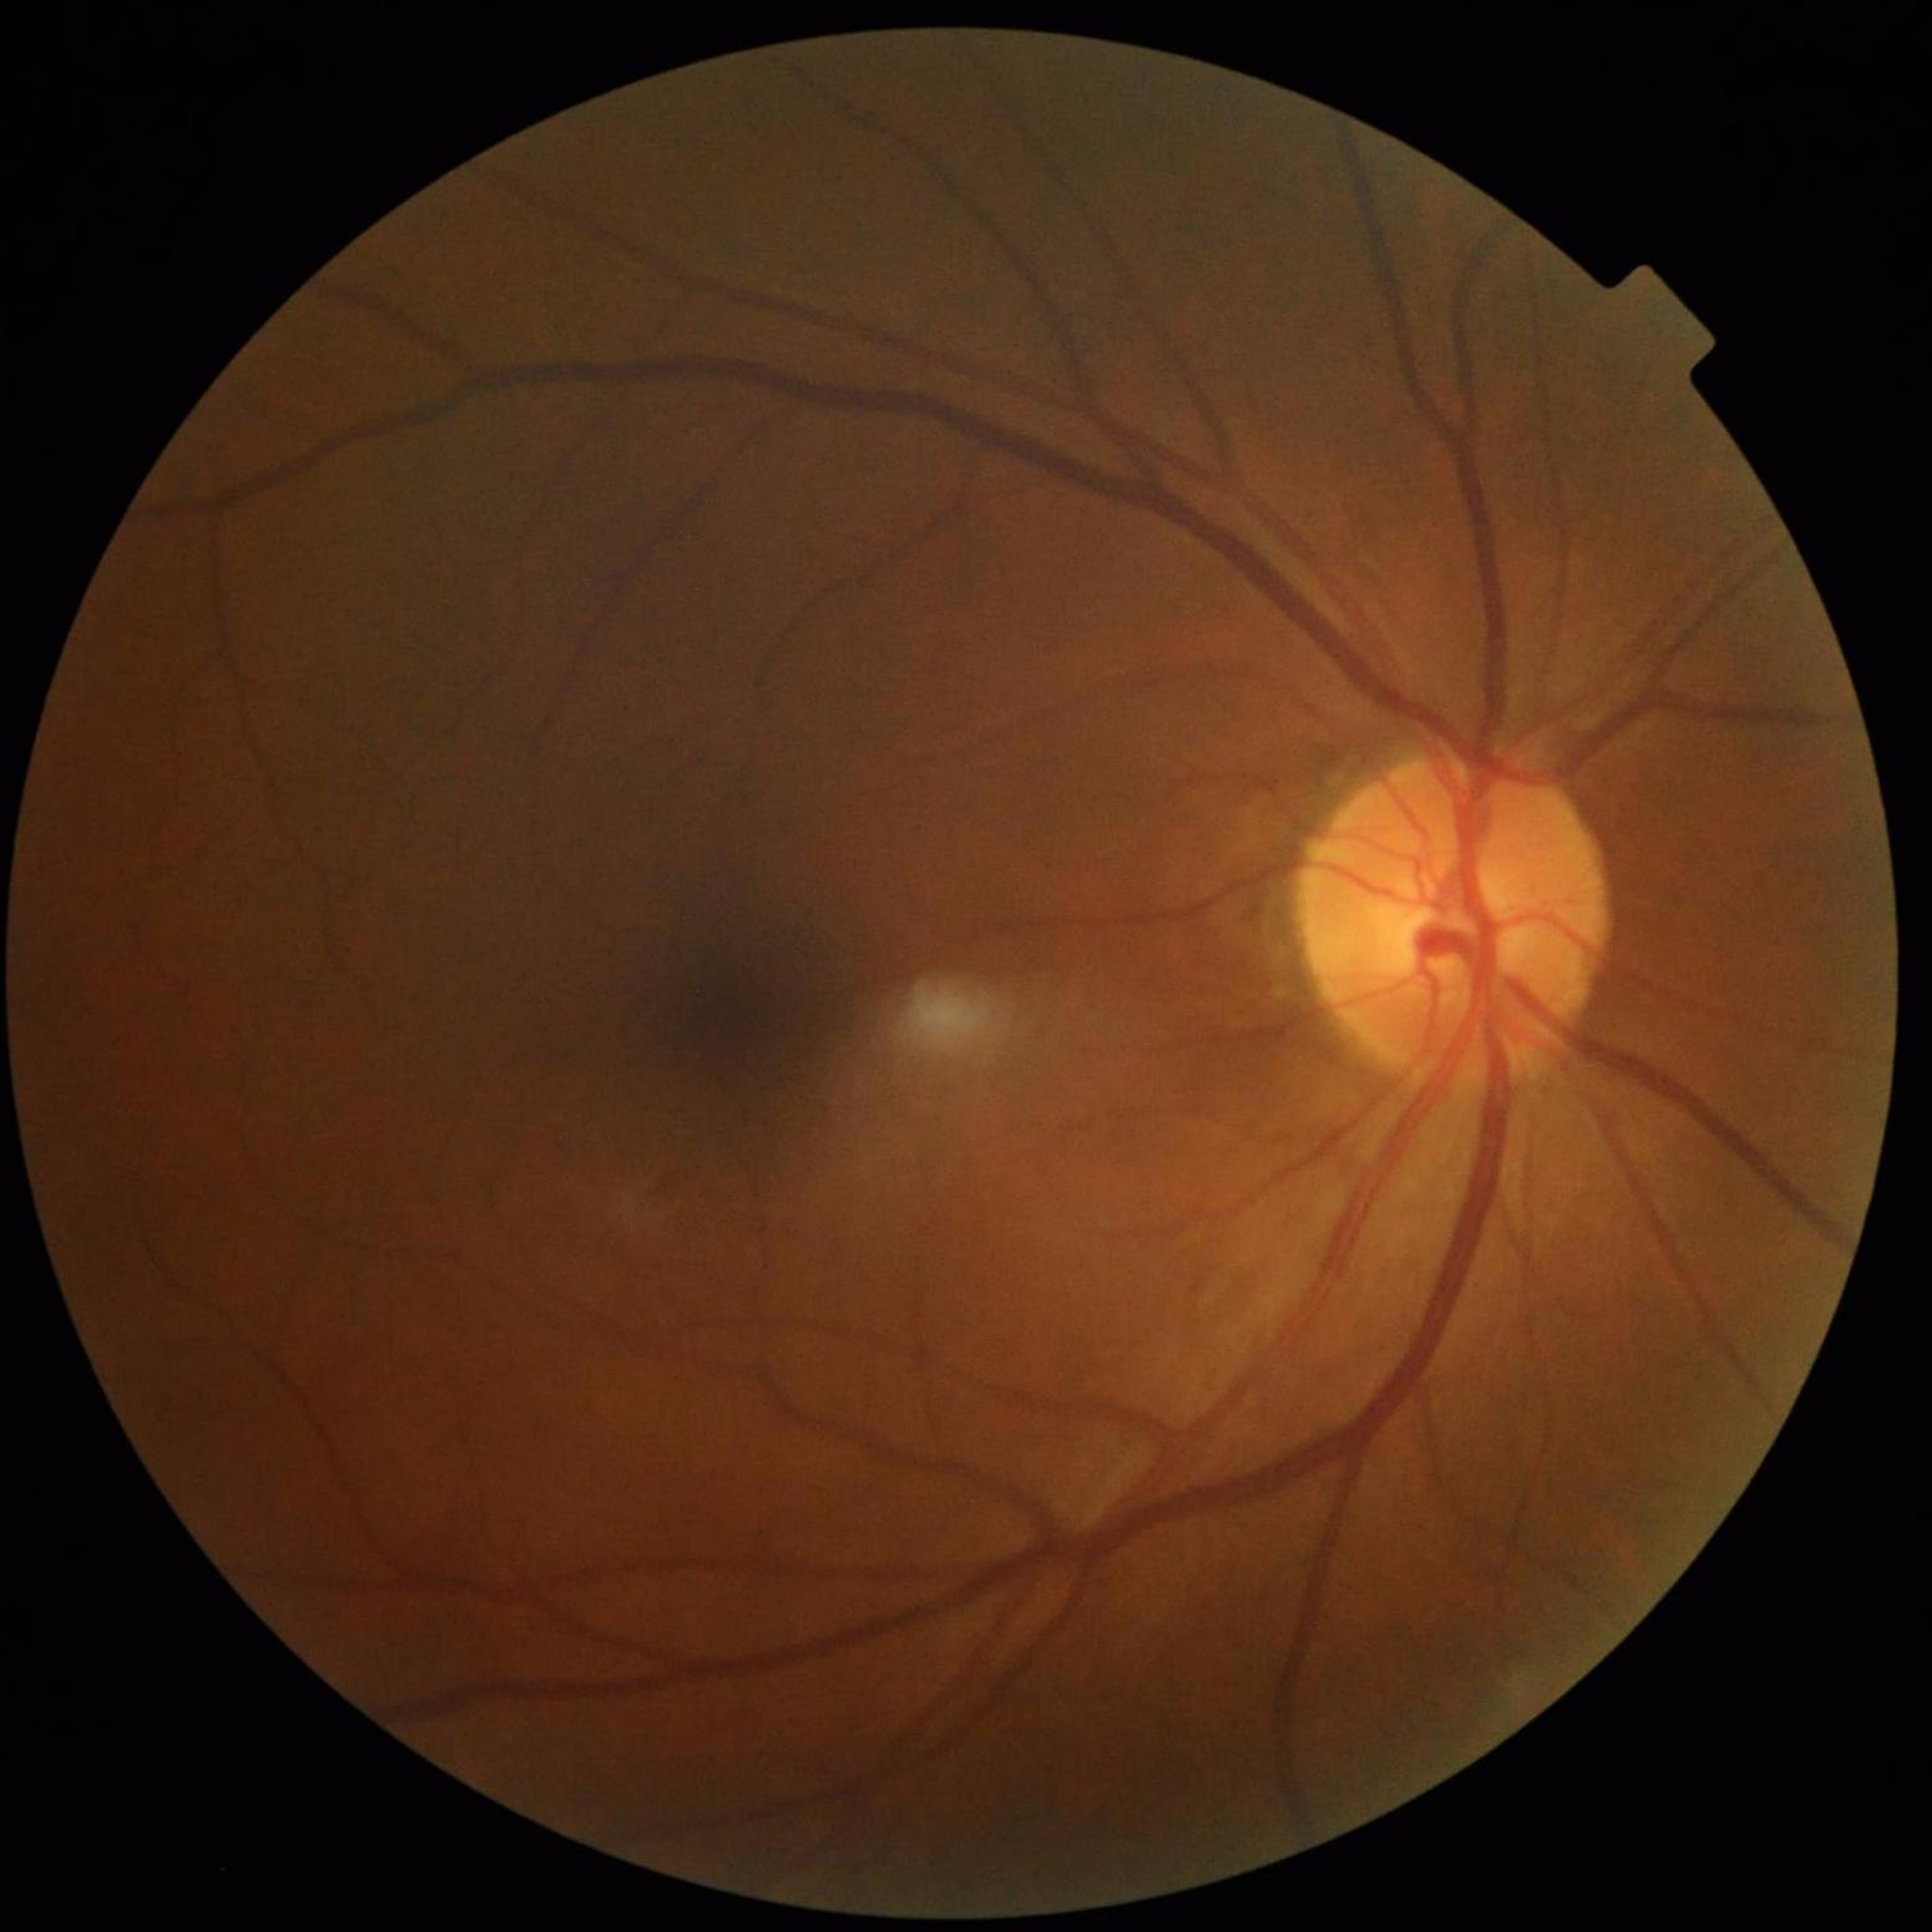
Image quality: contrast adequate, illumination and color satisfactory, no blur
Condition: diabetic retinopathy